Davis DR grading; 848 x 848 pixels; NIDEK AFC-230 fundus camera
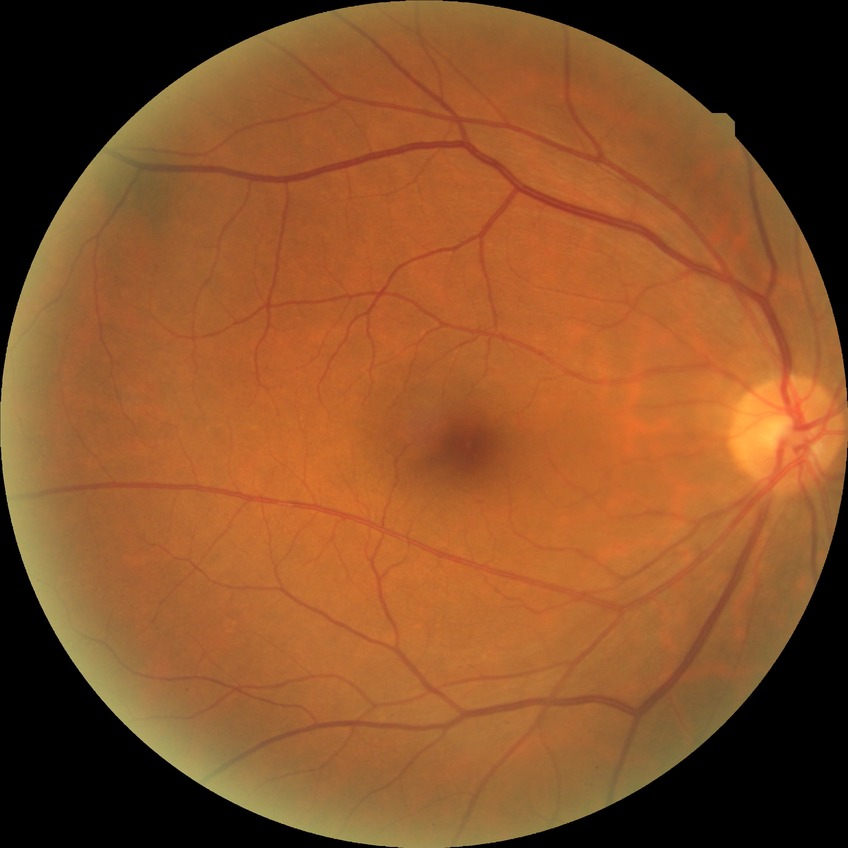
{
  "dr_impression": "no apparent DR",
  "davis_grade": "NDR"
}